Wide-field fundus photograph of an infant:
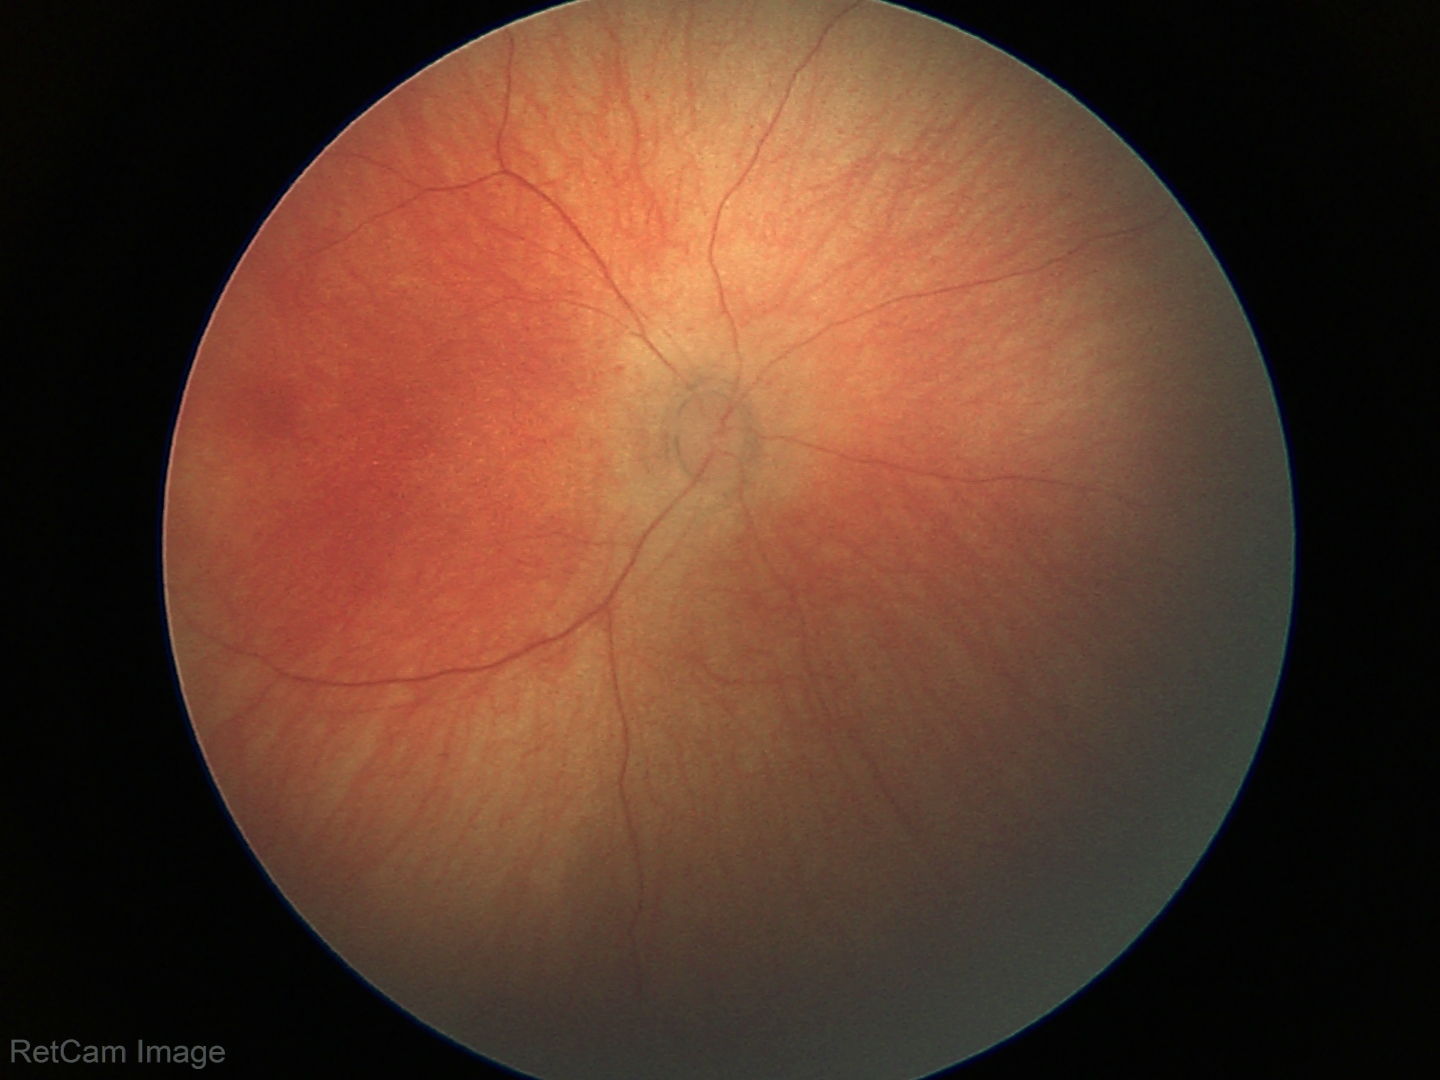 Assessment: physiological finding.